FOV: 45 degrees; posterior pole photograph.
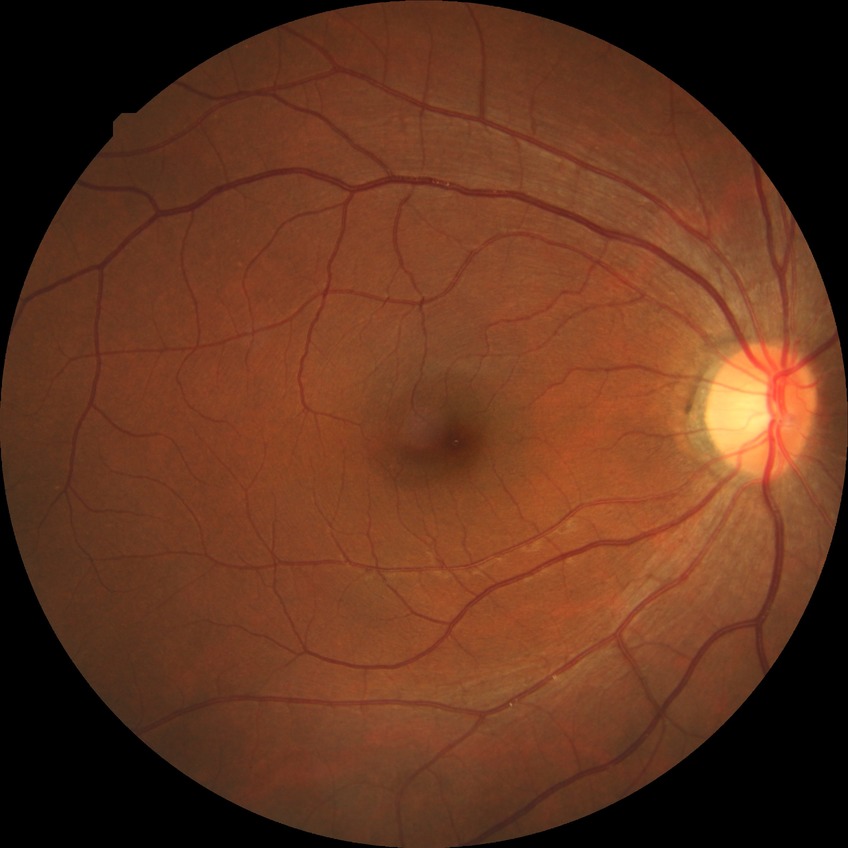 Diabetic retinopathy stage is no diabetic retinopathy.